45° FOV · 2352x1568: 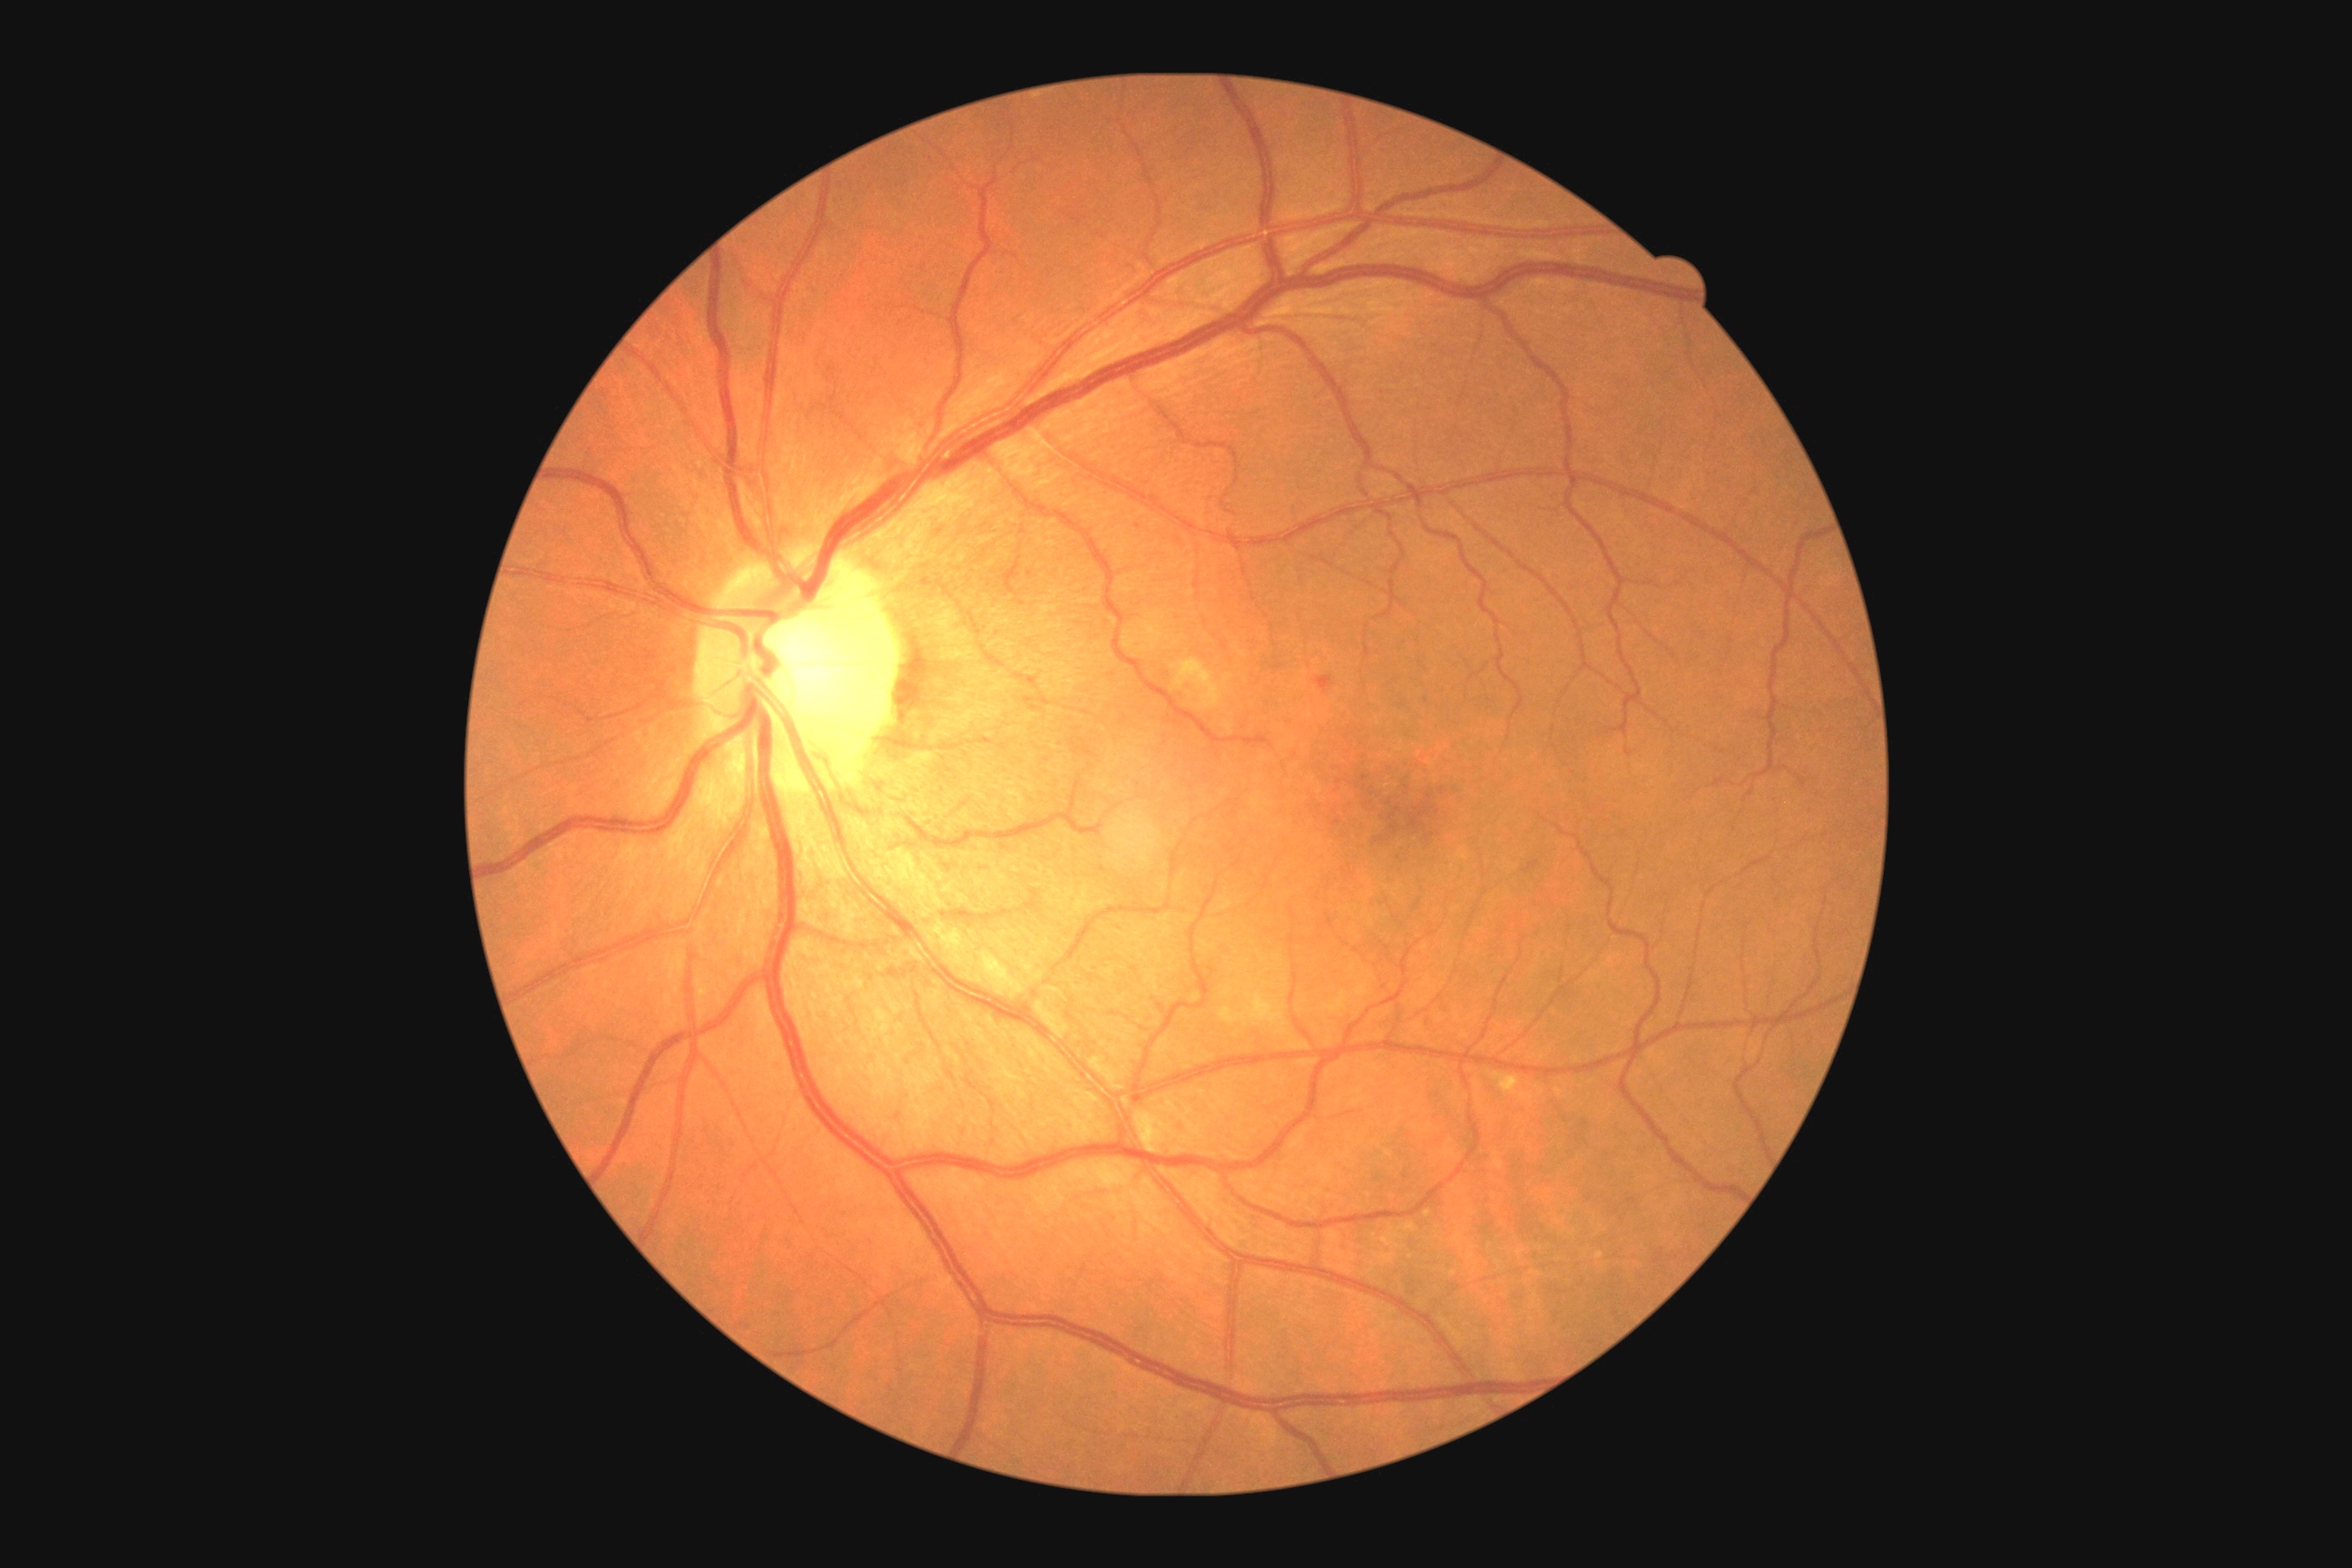 DR stage: moderate NPDR (grade 2).